2212 x 1659 pixels — 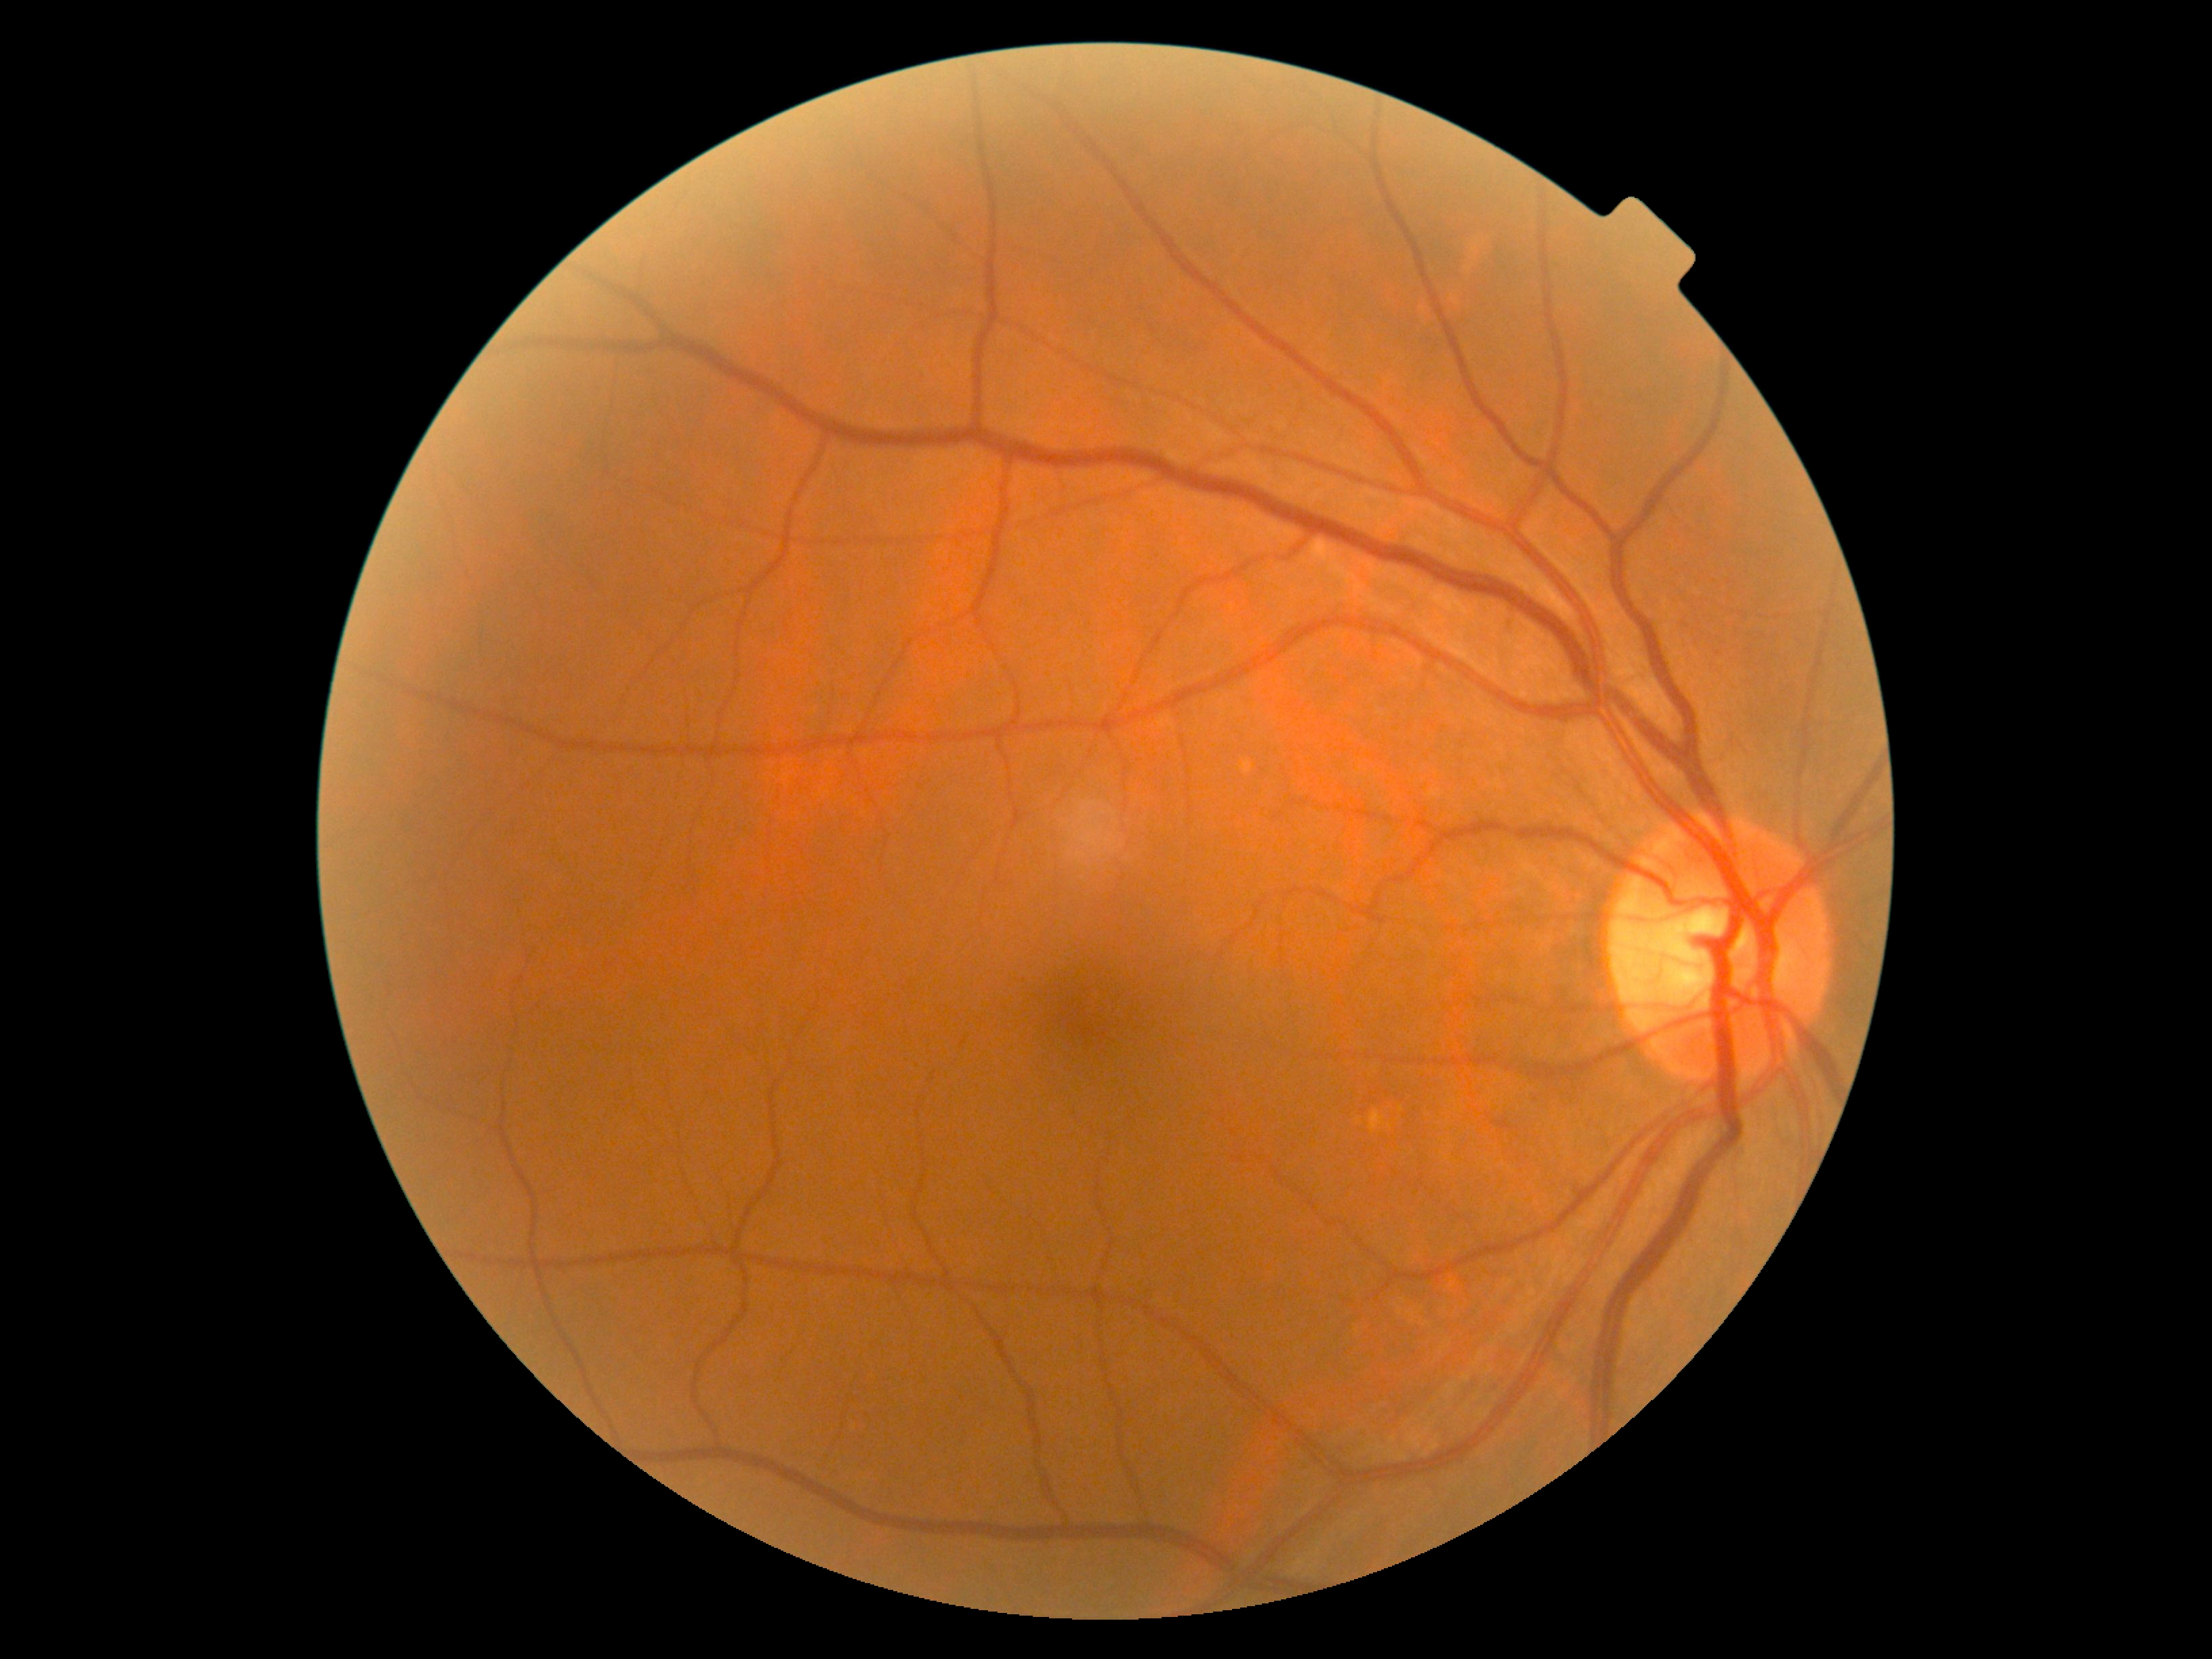

DR impression: no apparent DR; retinopathy: 0 — no visible signs of diabetic retinopathy.